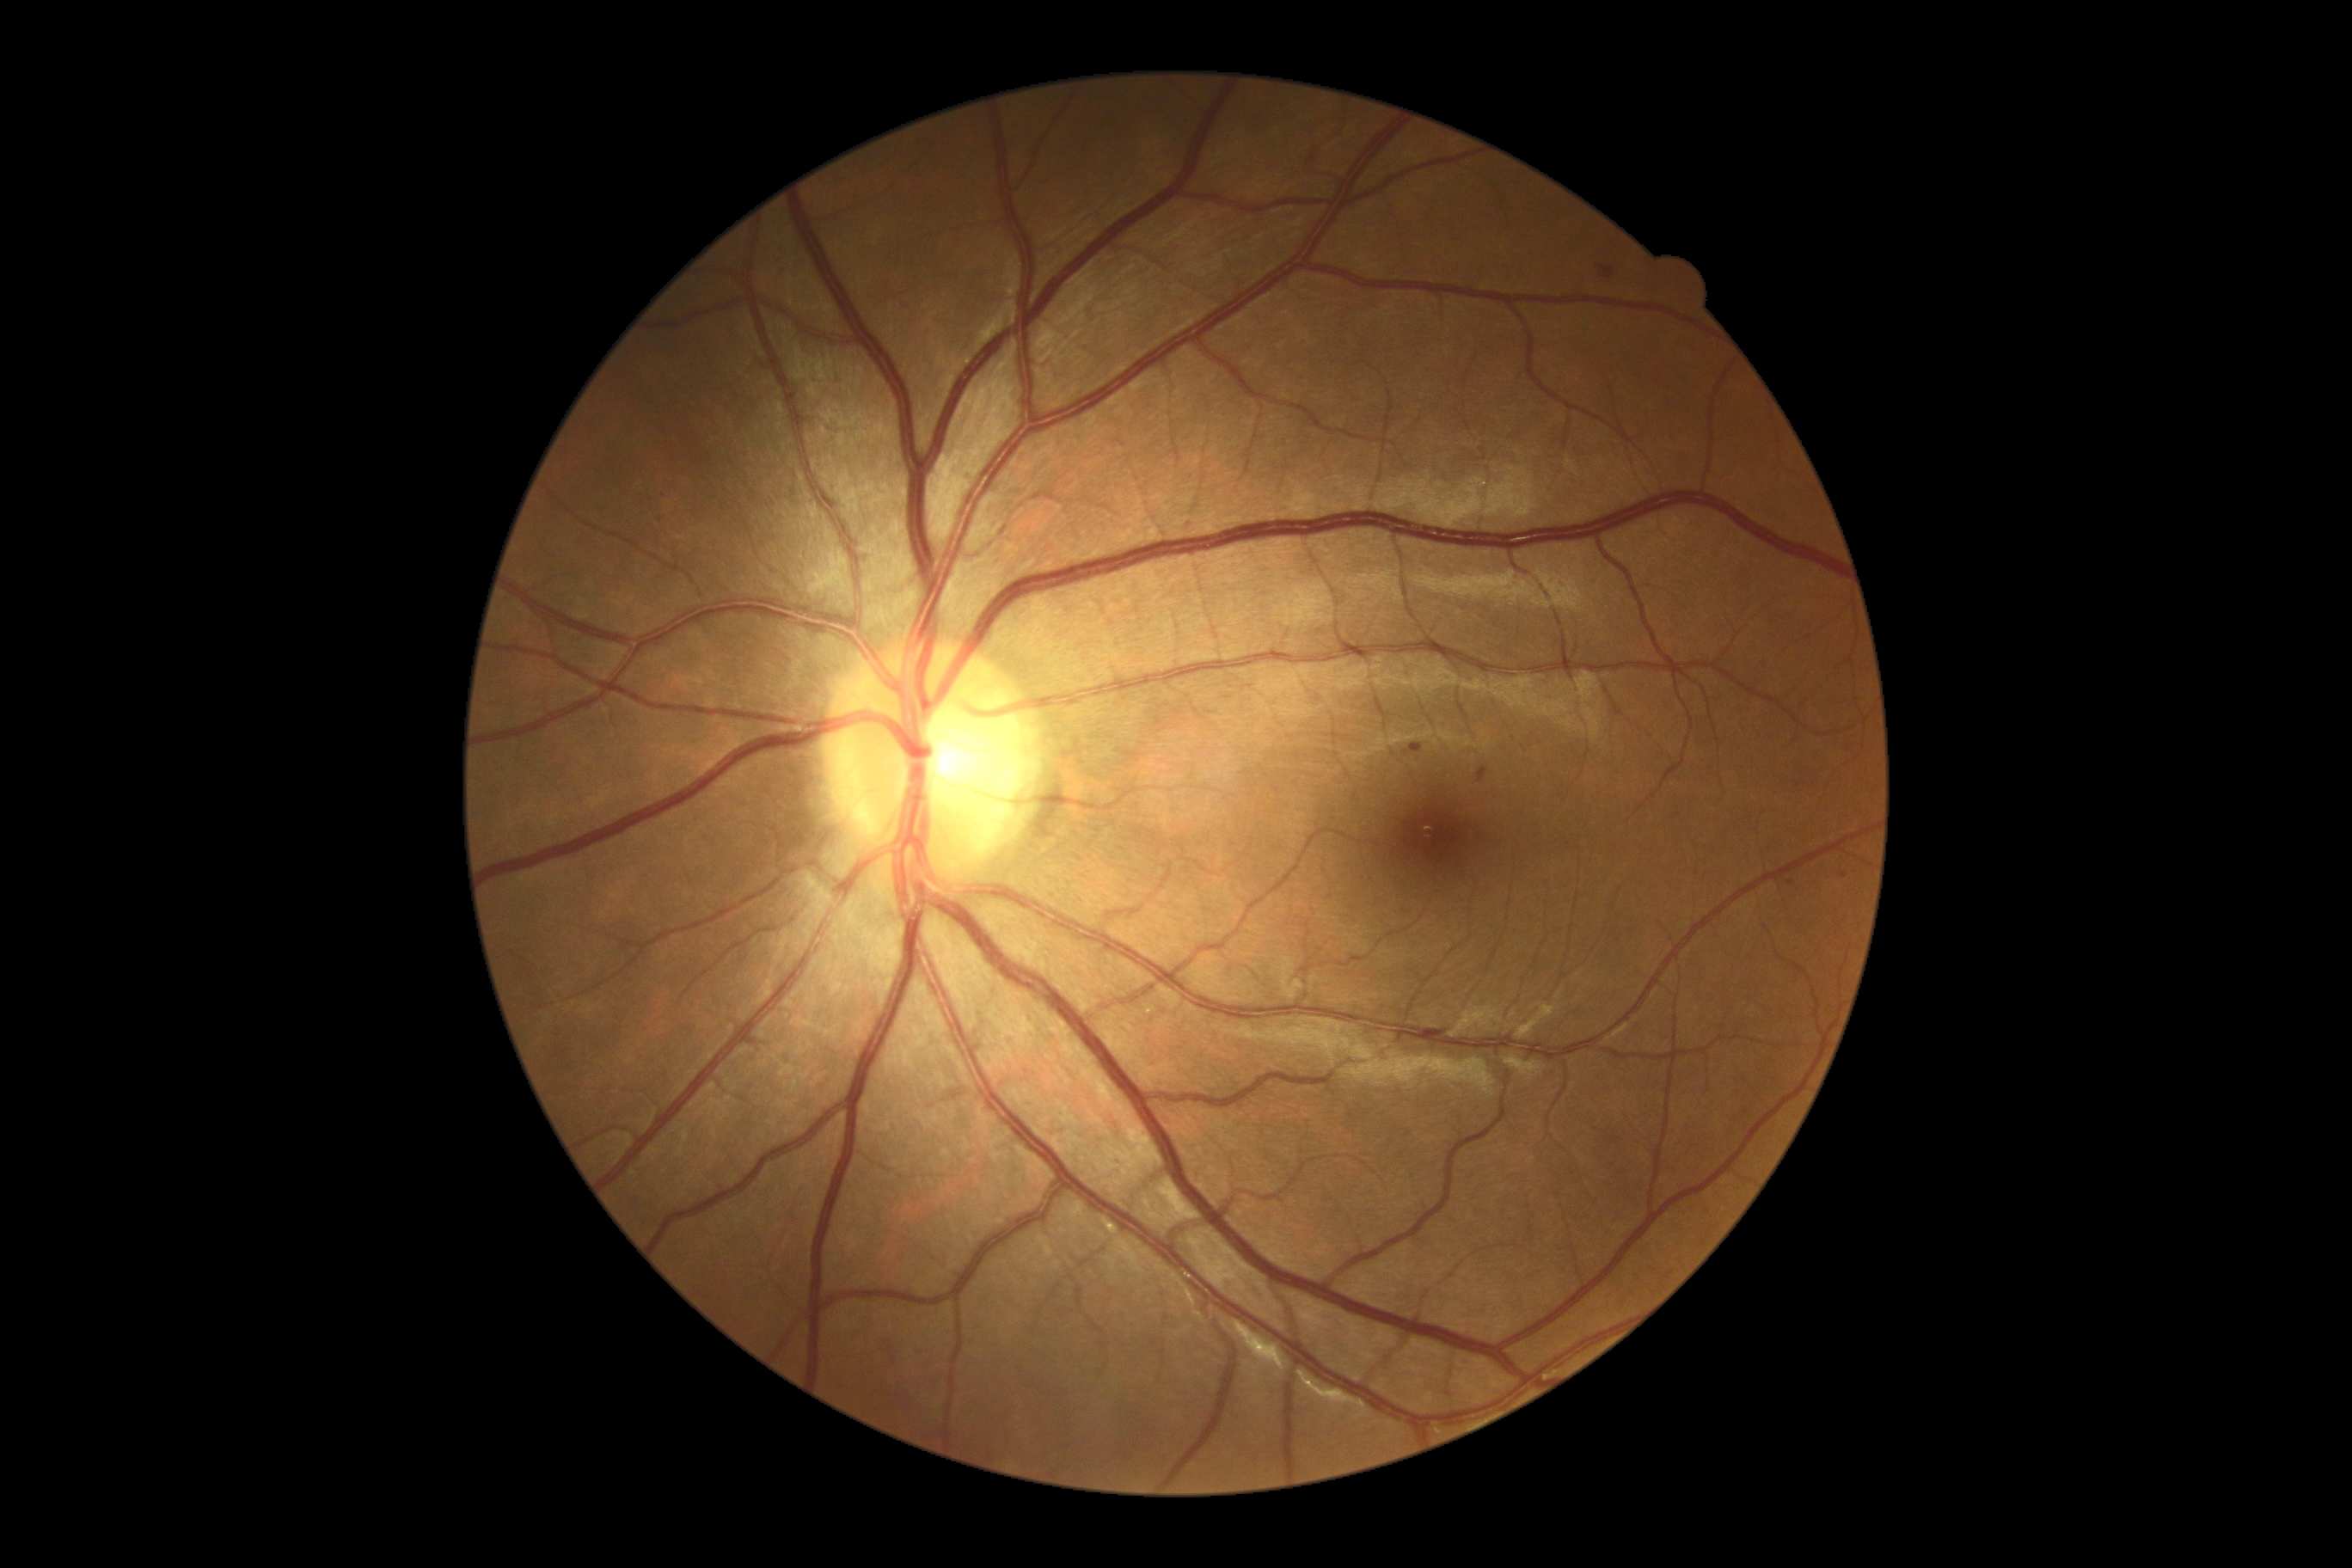
Diabetic retinopathy severity is grade 1 (mild NPDR)
soft exudates = not present
hemorrhages = {"left": 1600, "top": 266, "right": 1615, "bottom": 279}
hard exudates = not present
microaneurysms = {"left": 1476, "top": 768, "right": 1488, "bottom": 783} | {"left": 1411, "top": 744, "right": 1424, "bottom": 754}
Small microaneurysms approximately at 1844:876 | 1790:883